1240x1240px. Acquired on the Phoenix ICON. Infant wide-field retinal image:
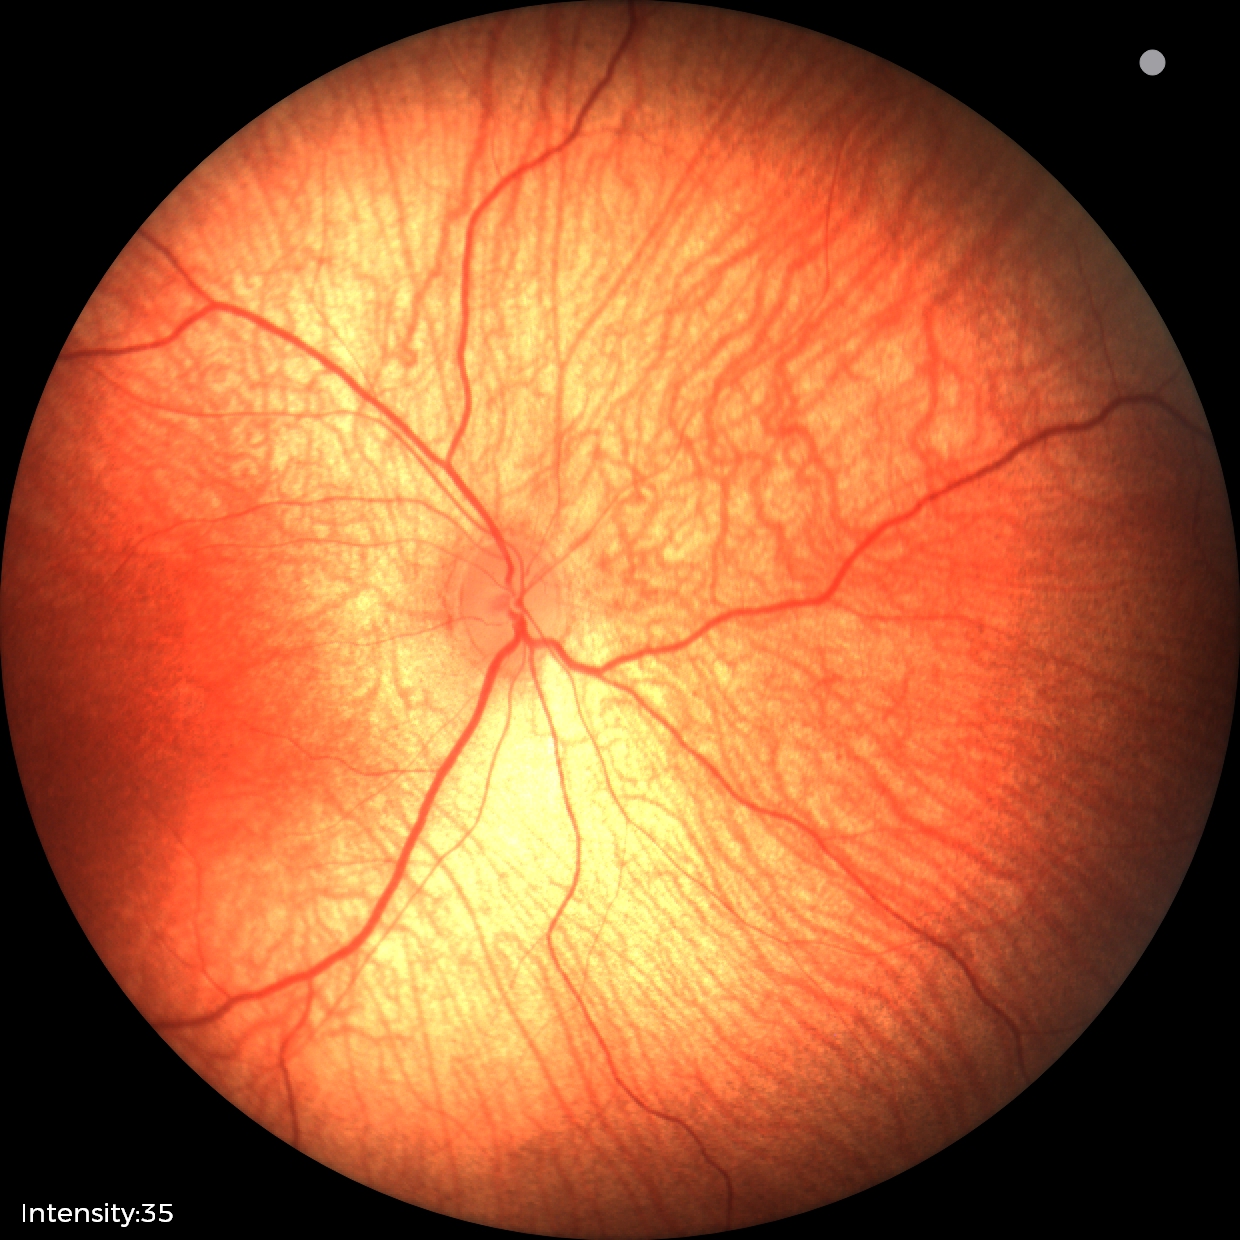 Examination with physiological retinal findings.